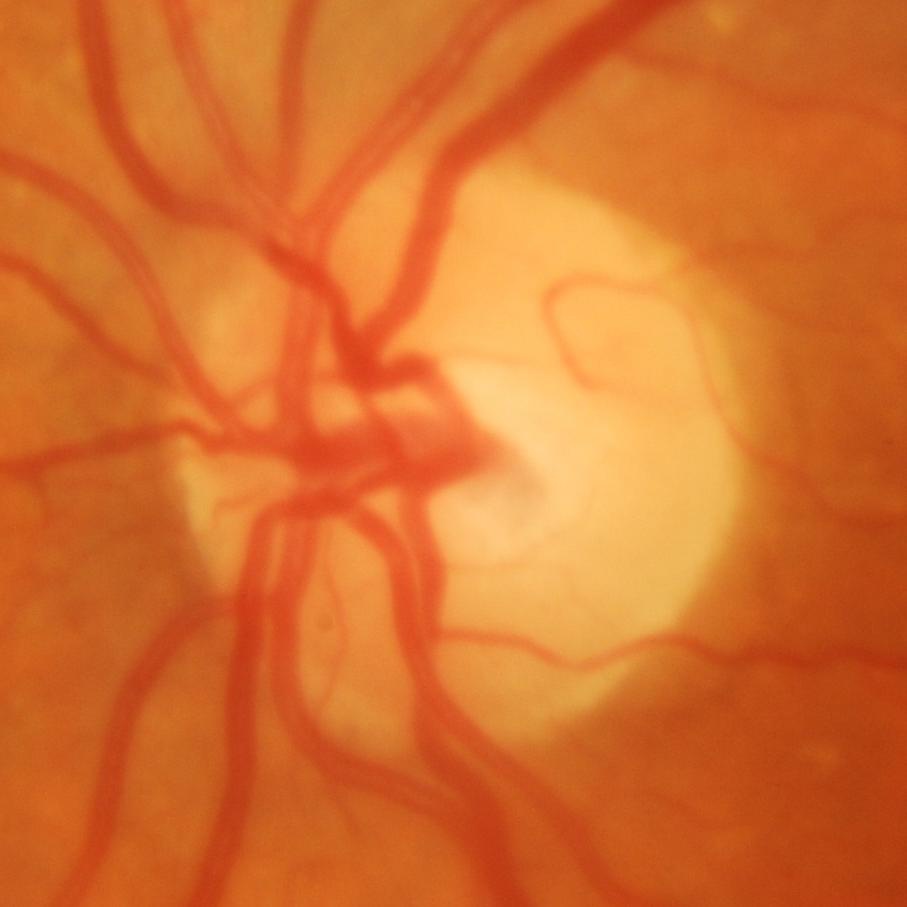 ONH-centered fundus image showing glaucomatous changes.